CFP
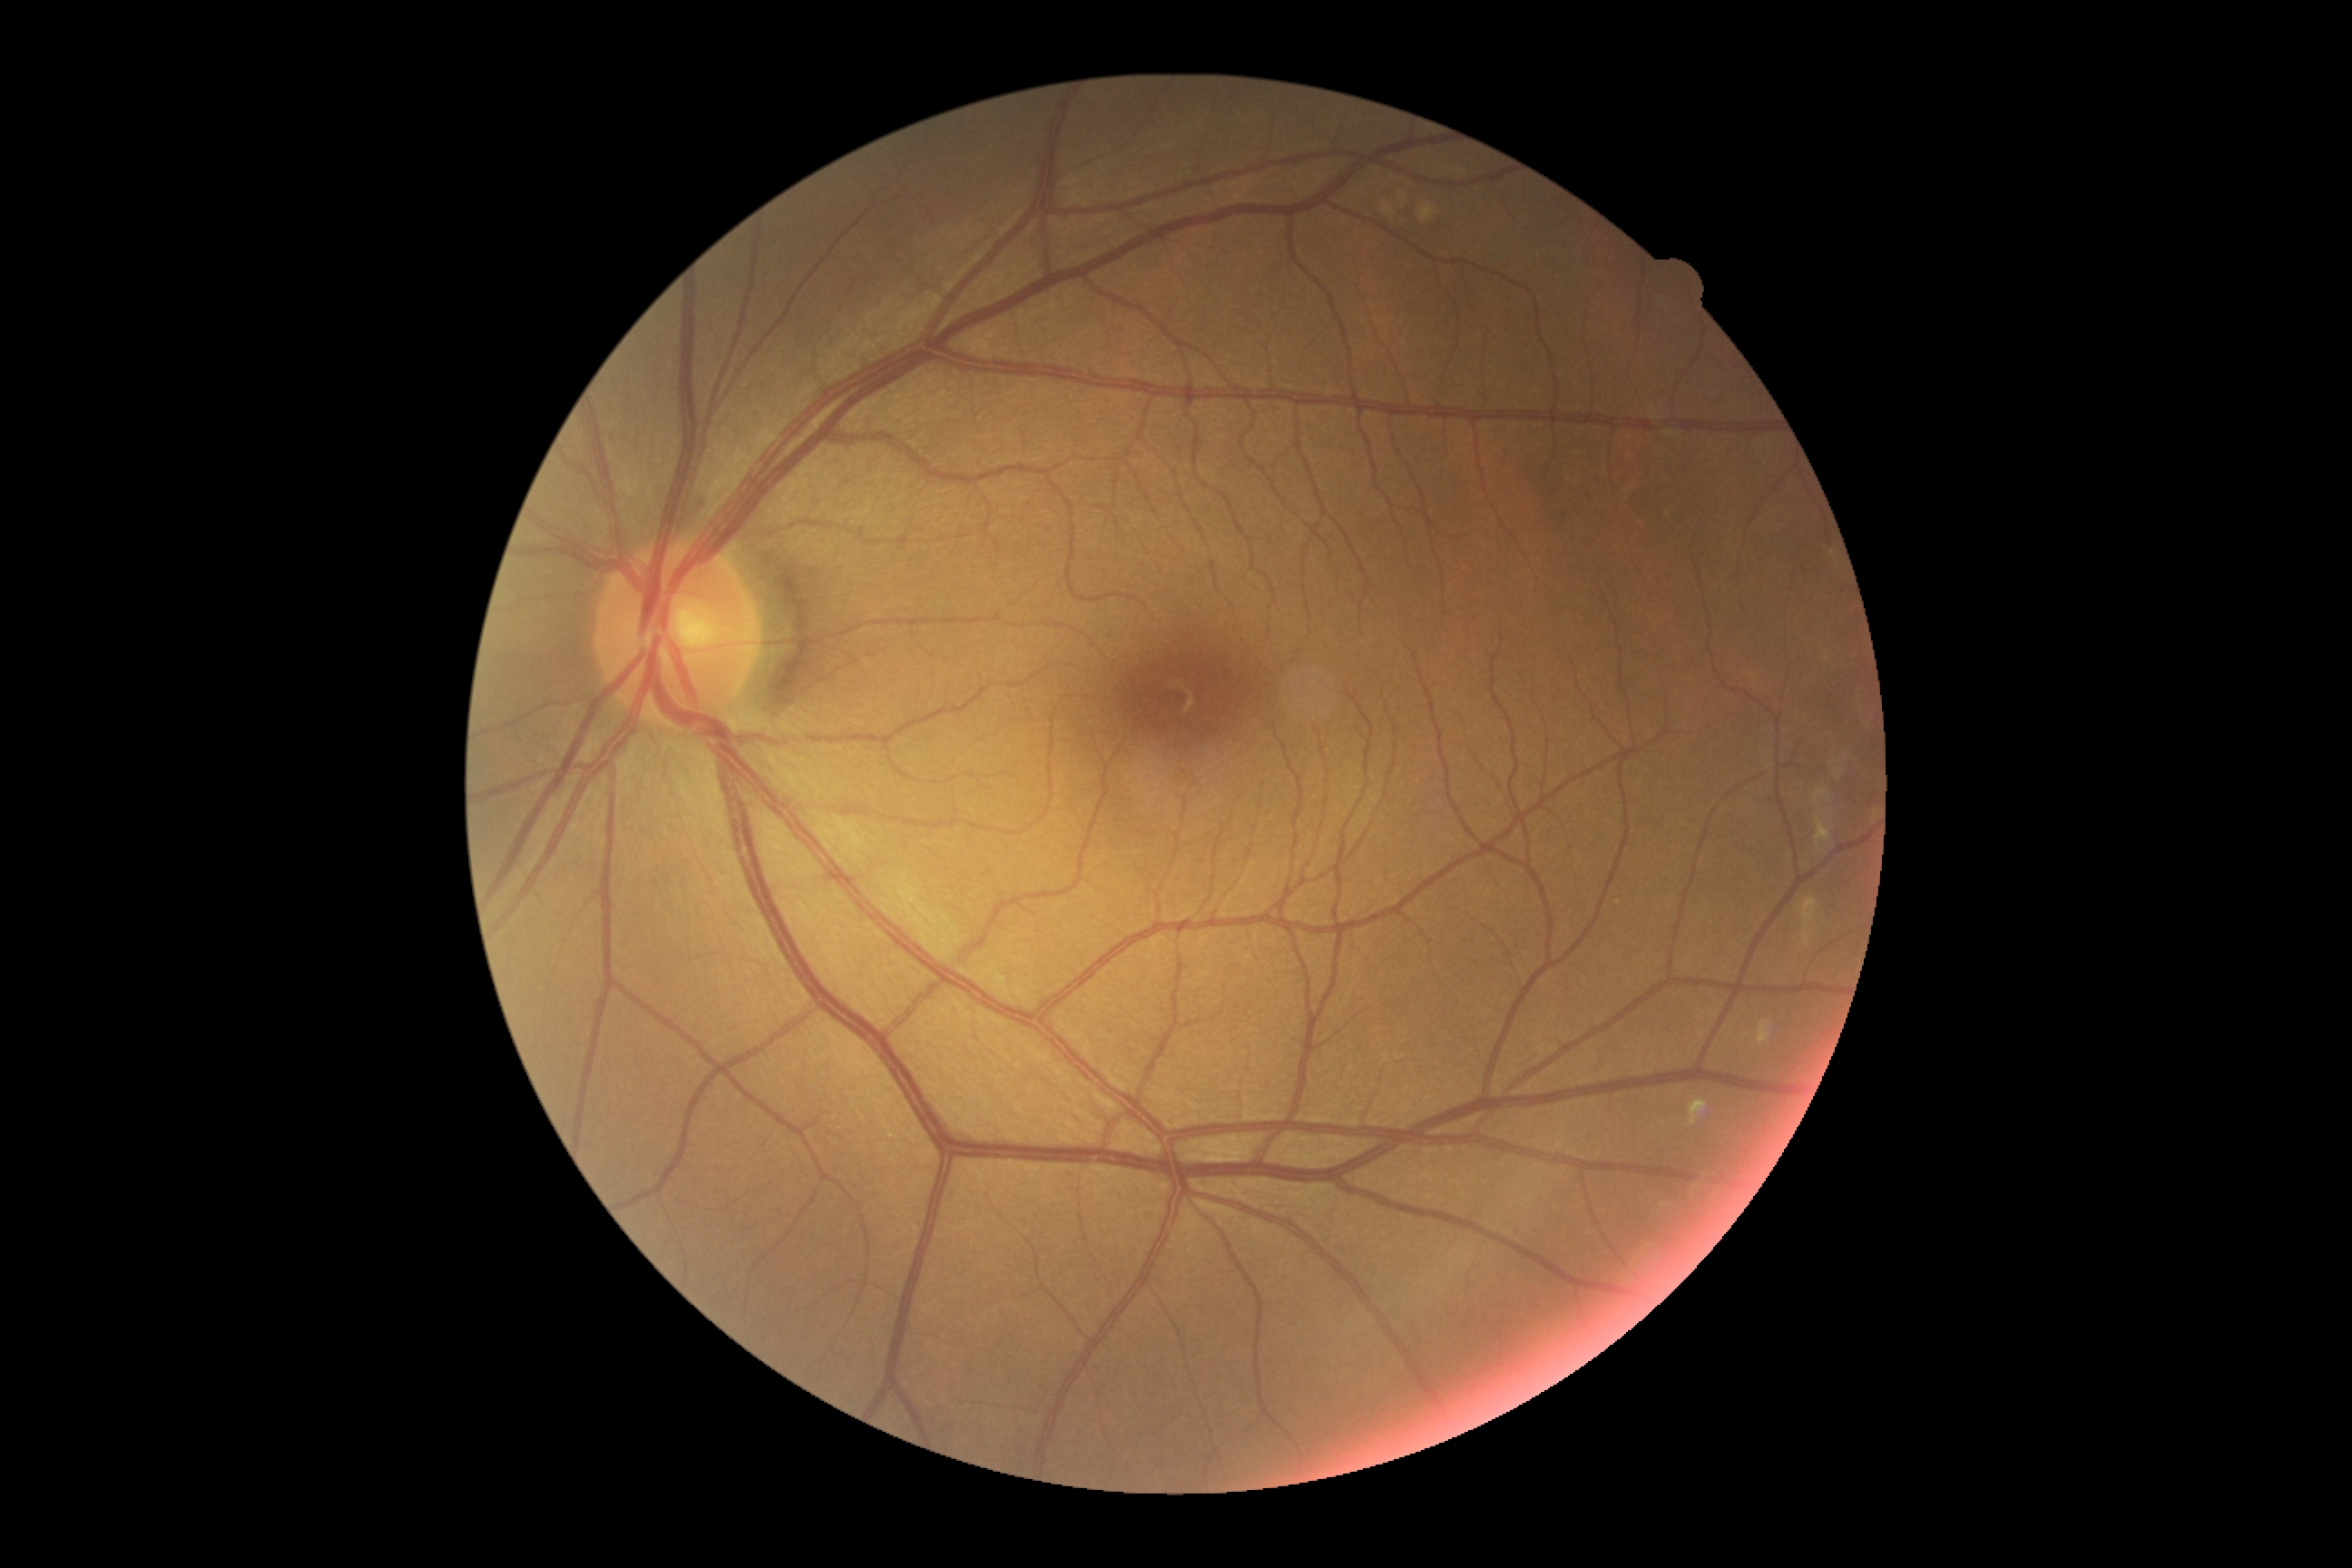
  dr_grade: grade 0 (no apparent retinopathy)